Without pupil dilation · 45-degree field of view · modified Davis grading.
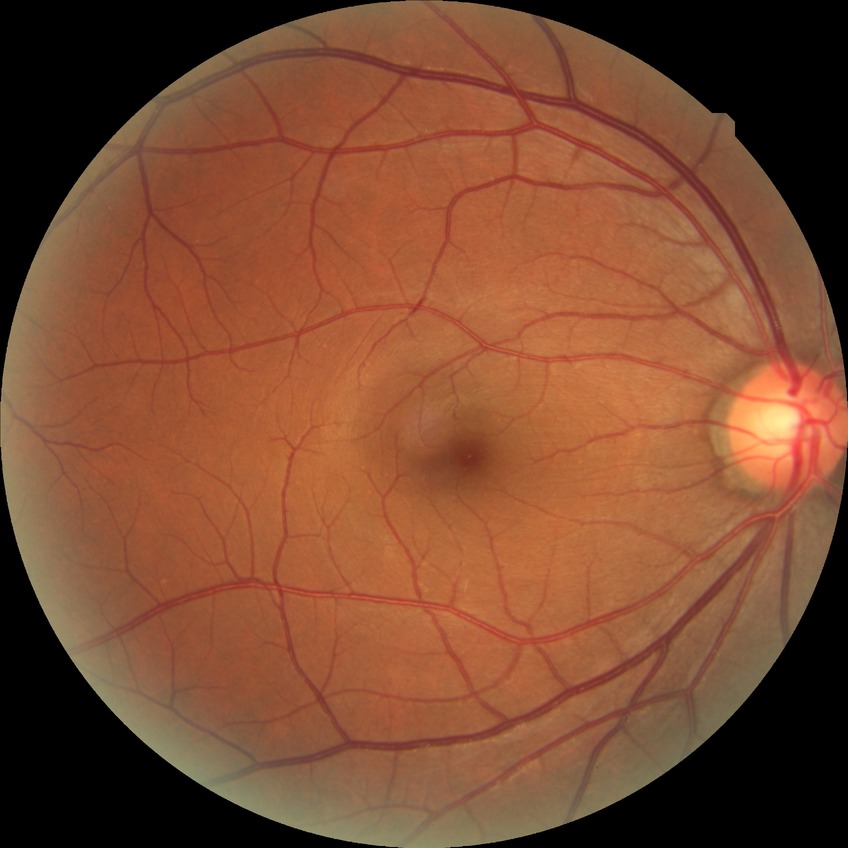 Findings:
• diabetic retinopathy (DR): no diabetic retinopathy (NDR)